Optic disc-centered crop, image size 240x240, camera: Nidek AFC-330: 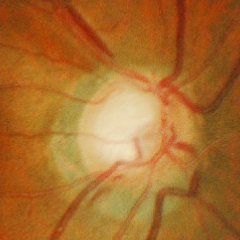 Glaucoma status = early glaucomatous changes. (Criteria: glaucomatous retinal nerve fiber layer defects on red-free fundus photography without visual field defects.)